Captured with the Phoenix ICON (100° field of view) · infant wide-field retinal image.
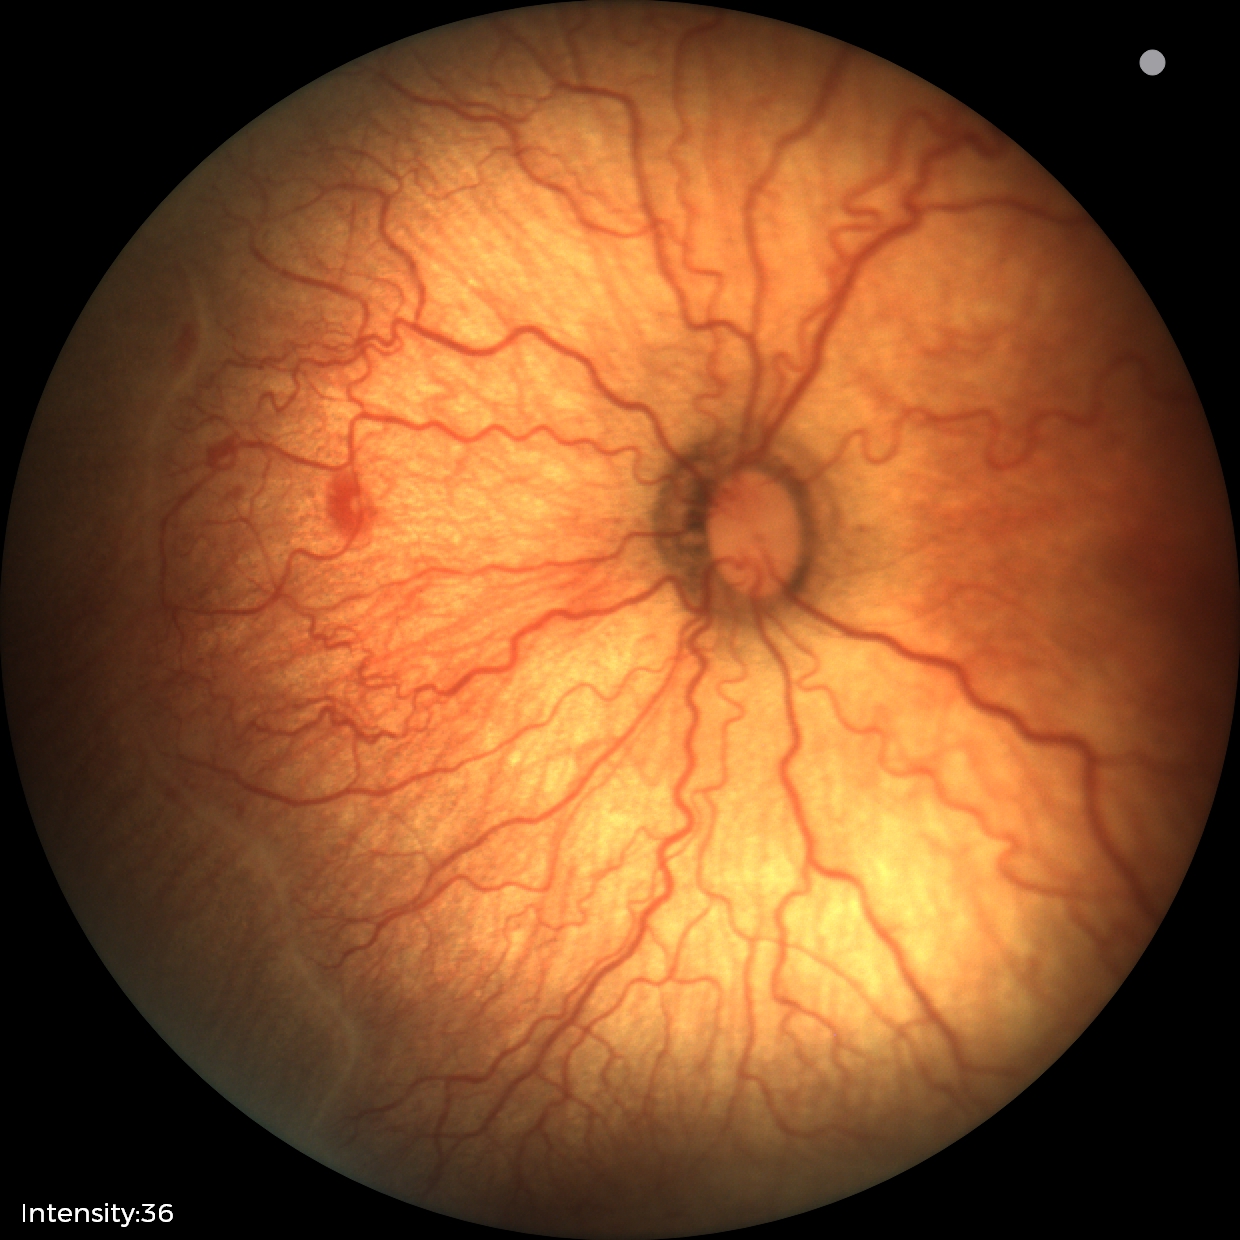

Plus disease present. Examination diagnosed as ROP stage 2.